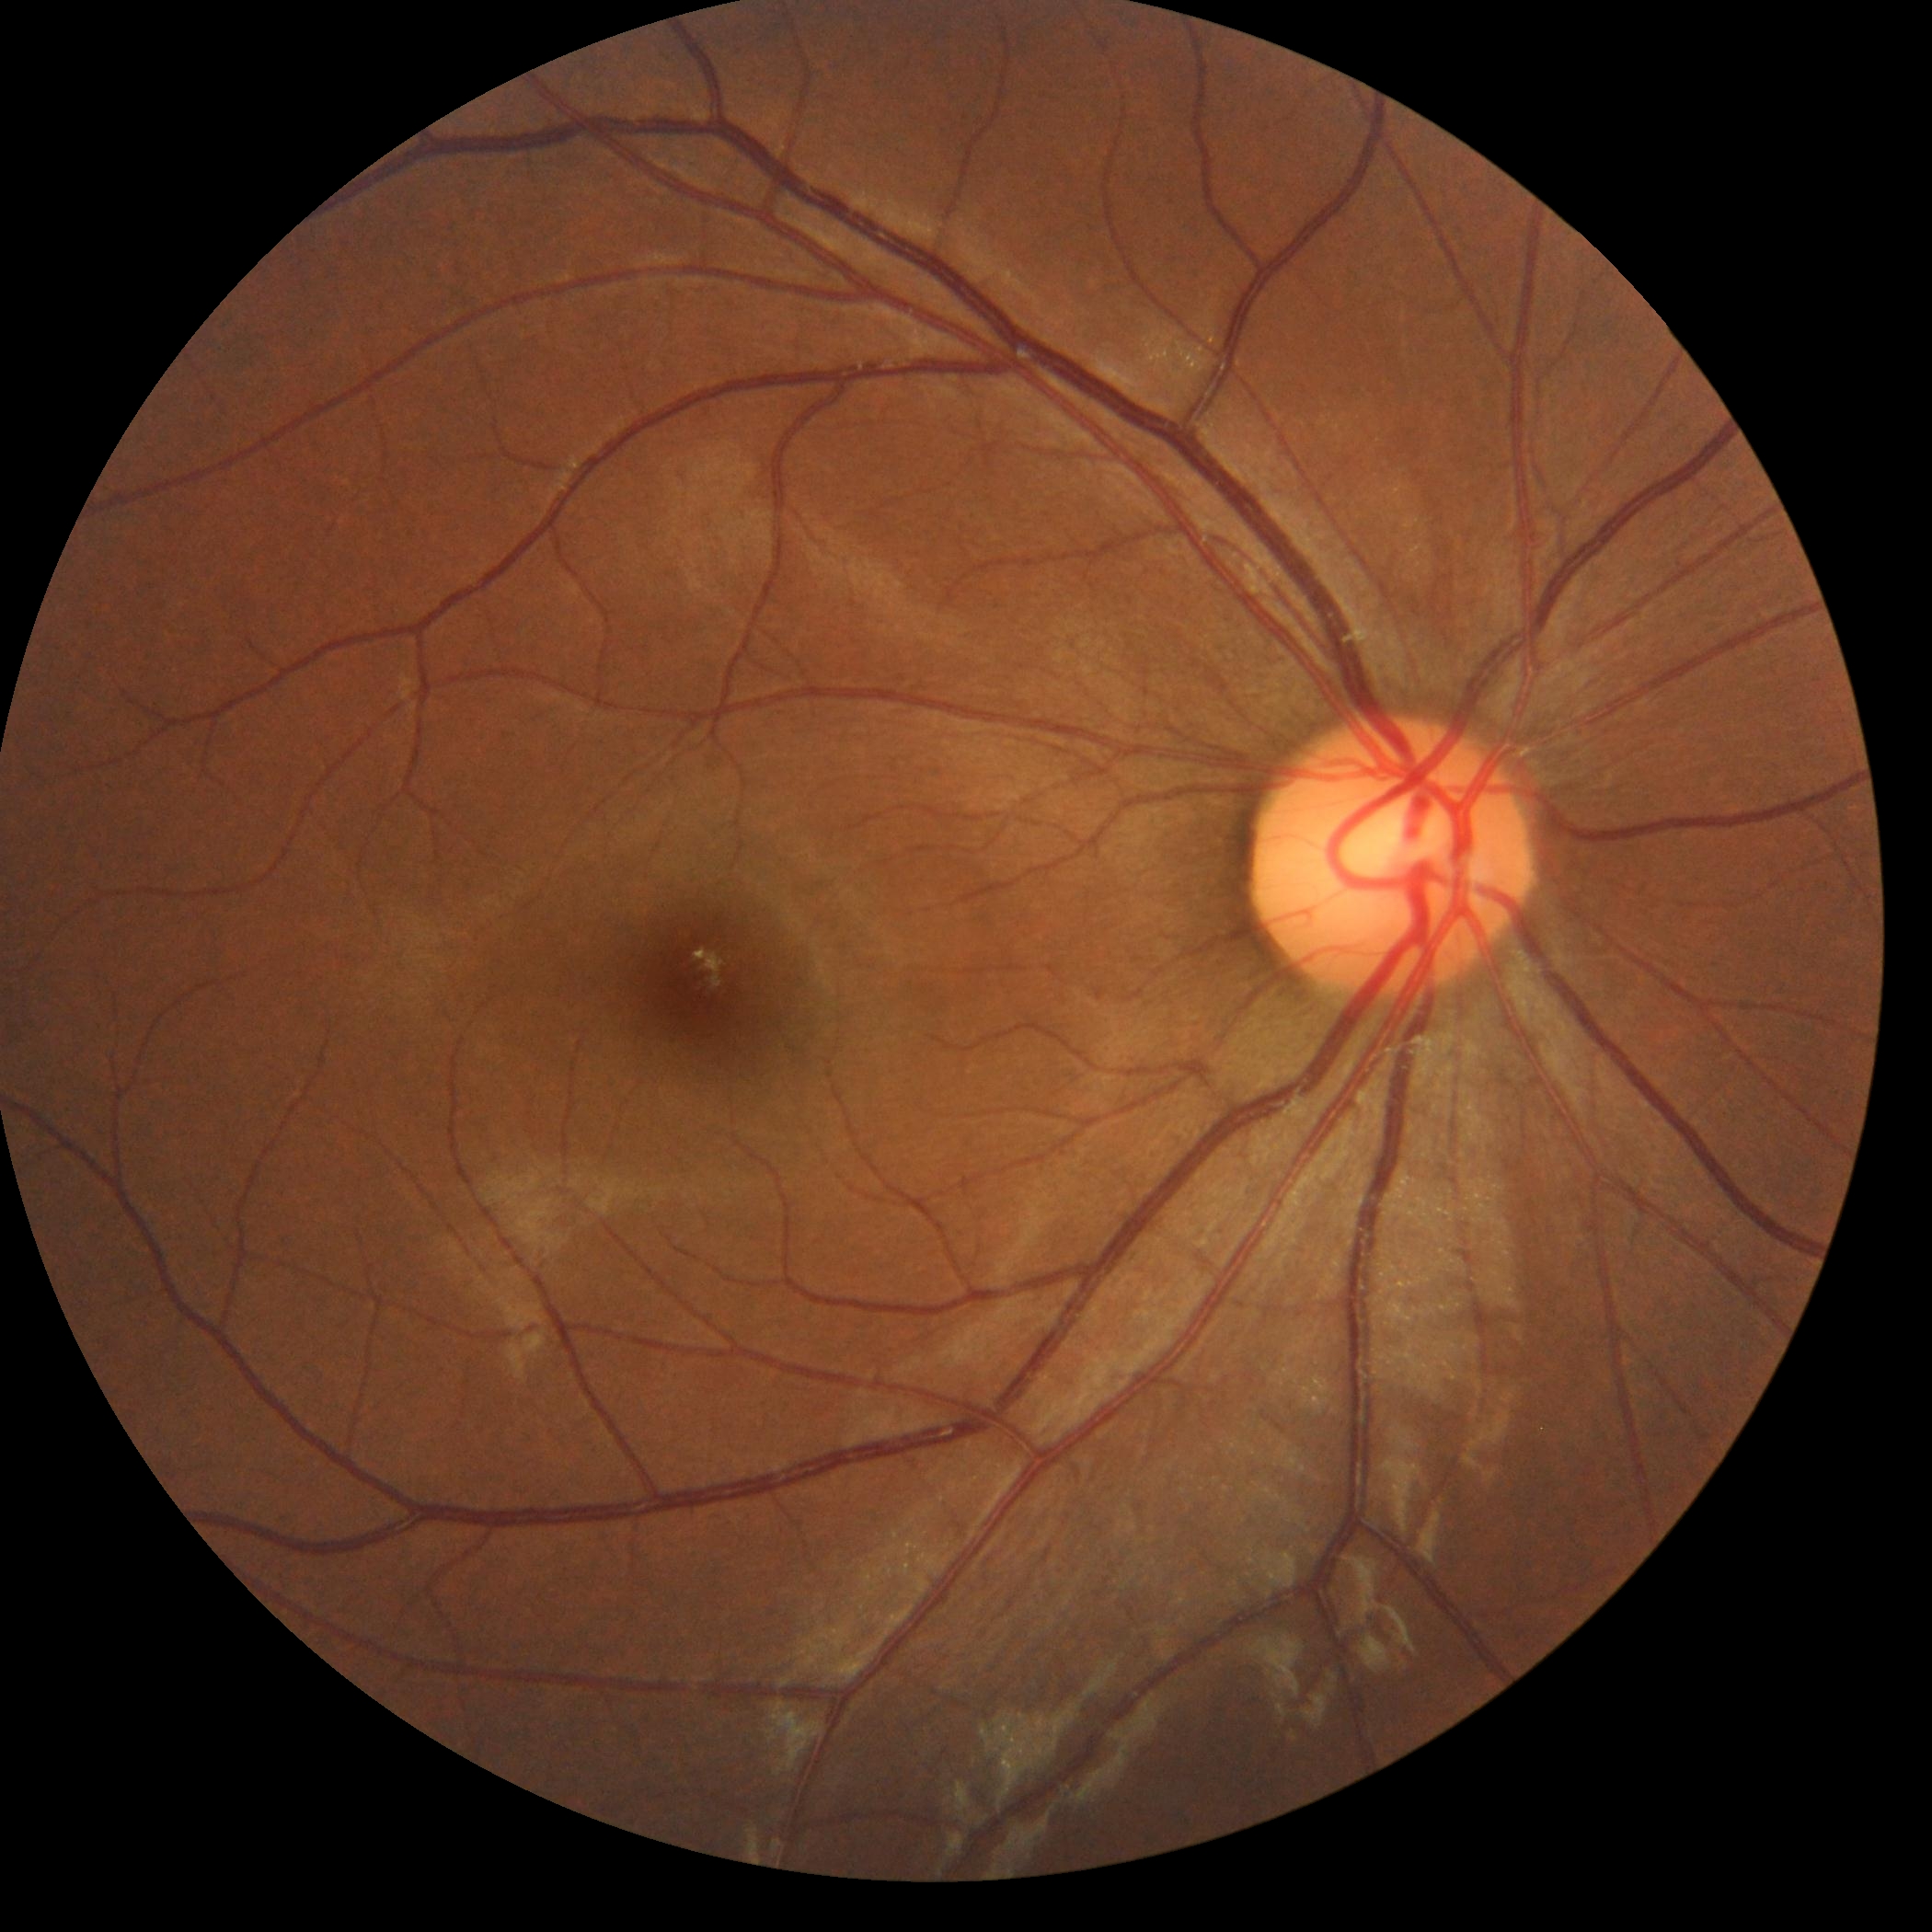 Retinopathy grade is 0 (no apparent retinopathy).